NIDEK AFC-230. 45° FOV — 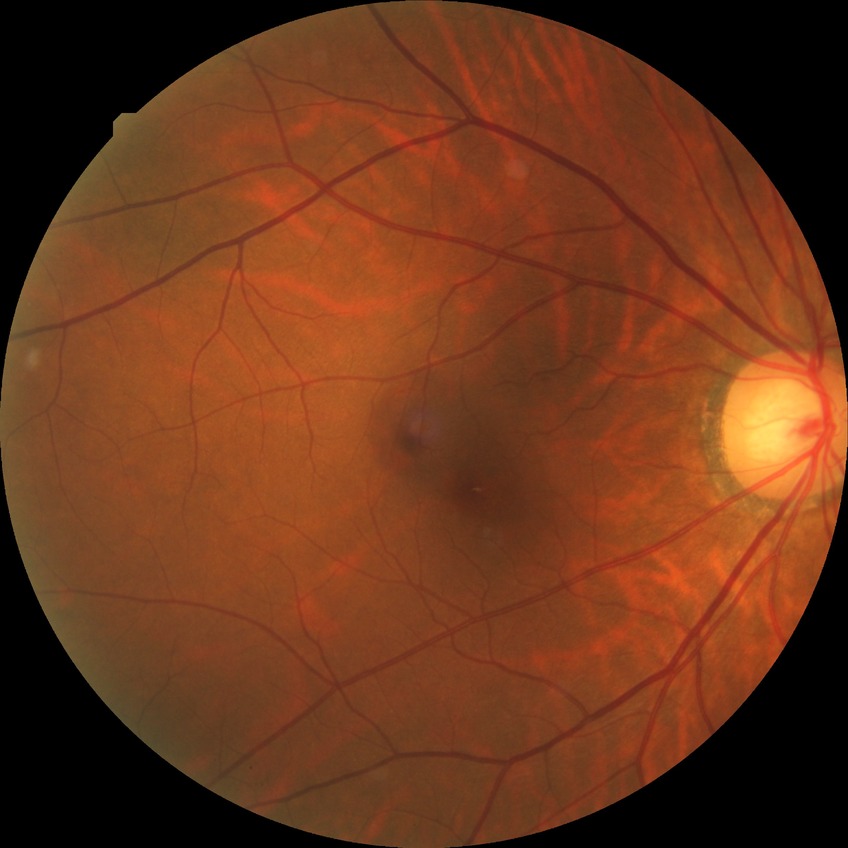 davis_grade: no diabetic retinopathy